Infant wide-field retinal image
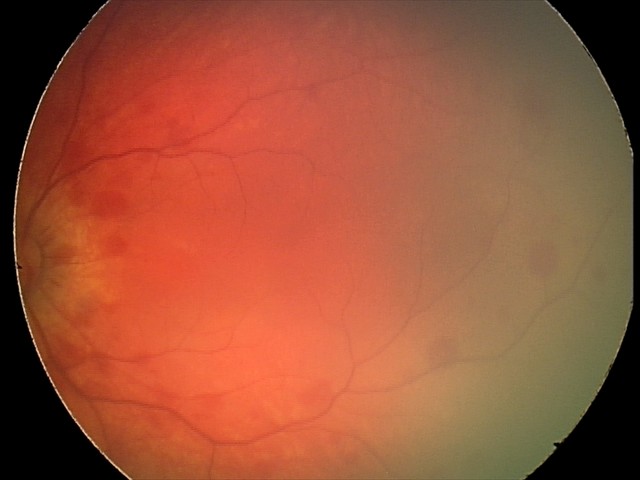 Screening diagnosis: retinal hemorrhages.